45° field of view · without pupil dilation · acquired with a NIDEK AFC-230 · 848 x 848 pixels.
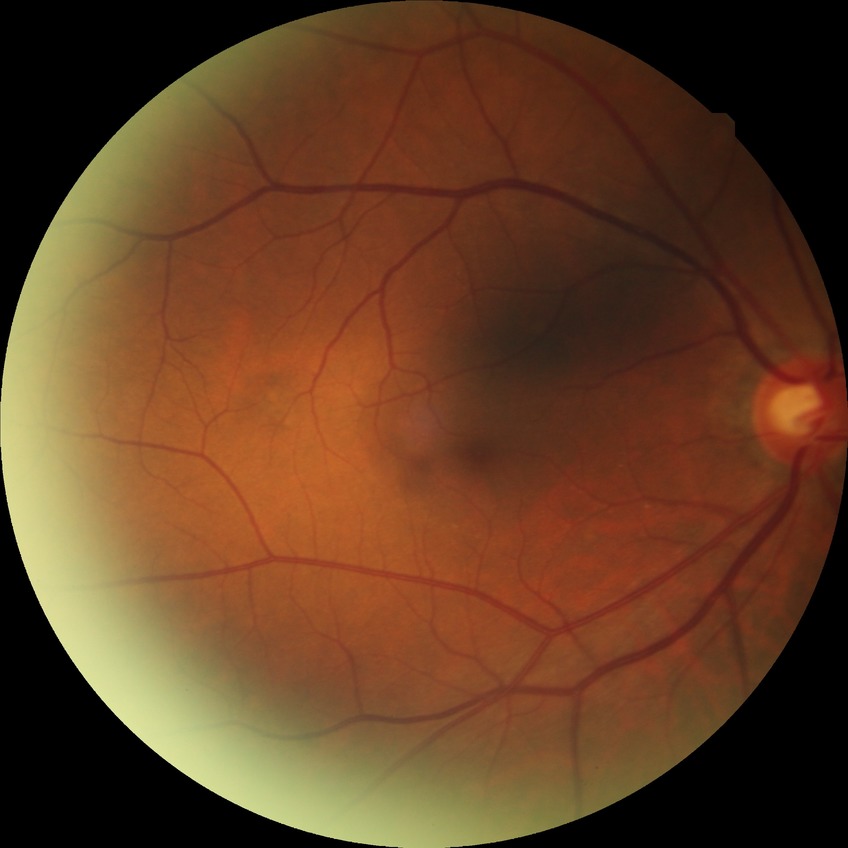 – diabetic retinopathy (DR) — no diabetic retinopathy (NDR)